Image size 2352x1568. Fundus photo. 45-degree field of view — 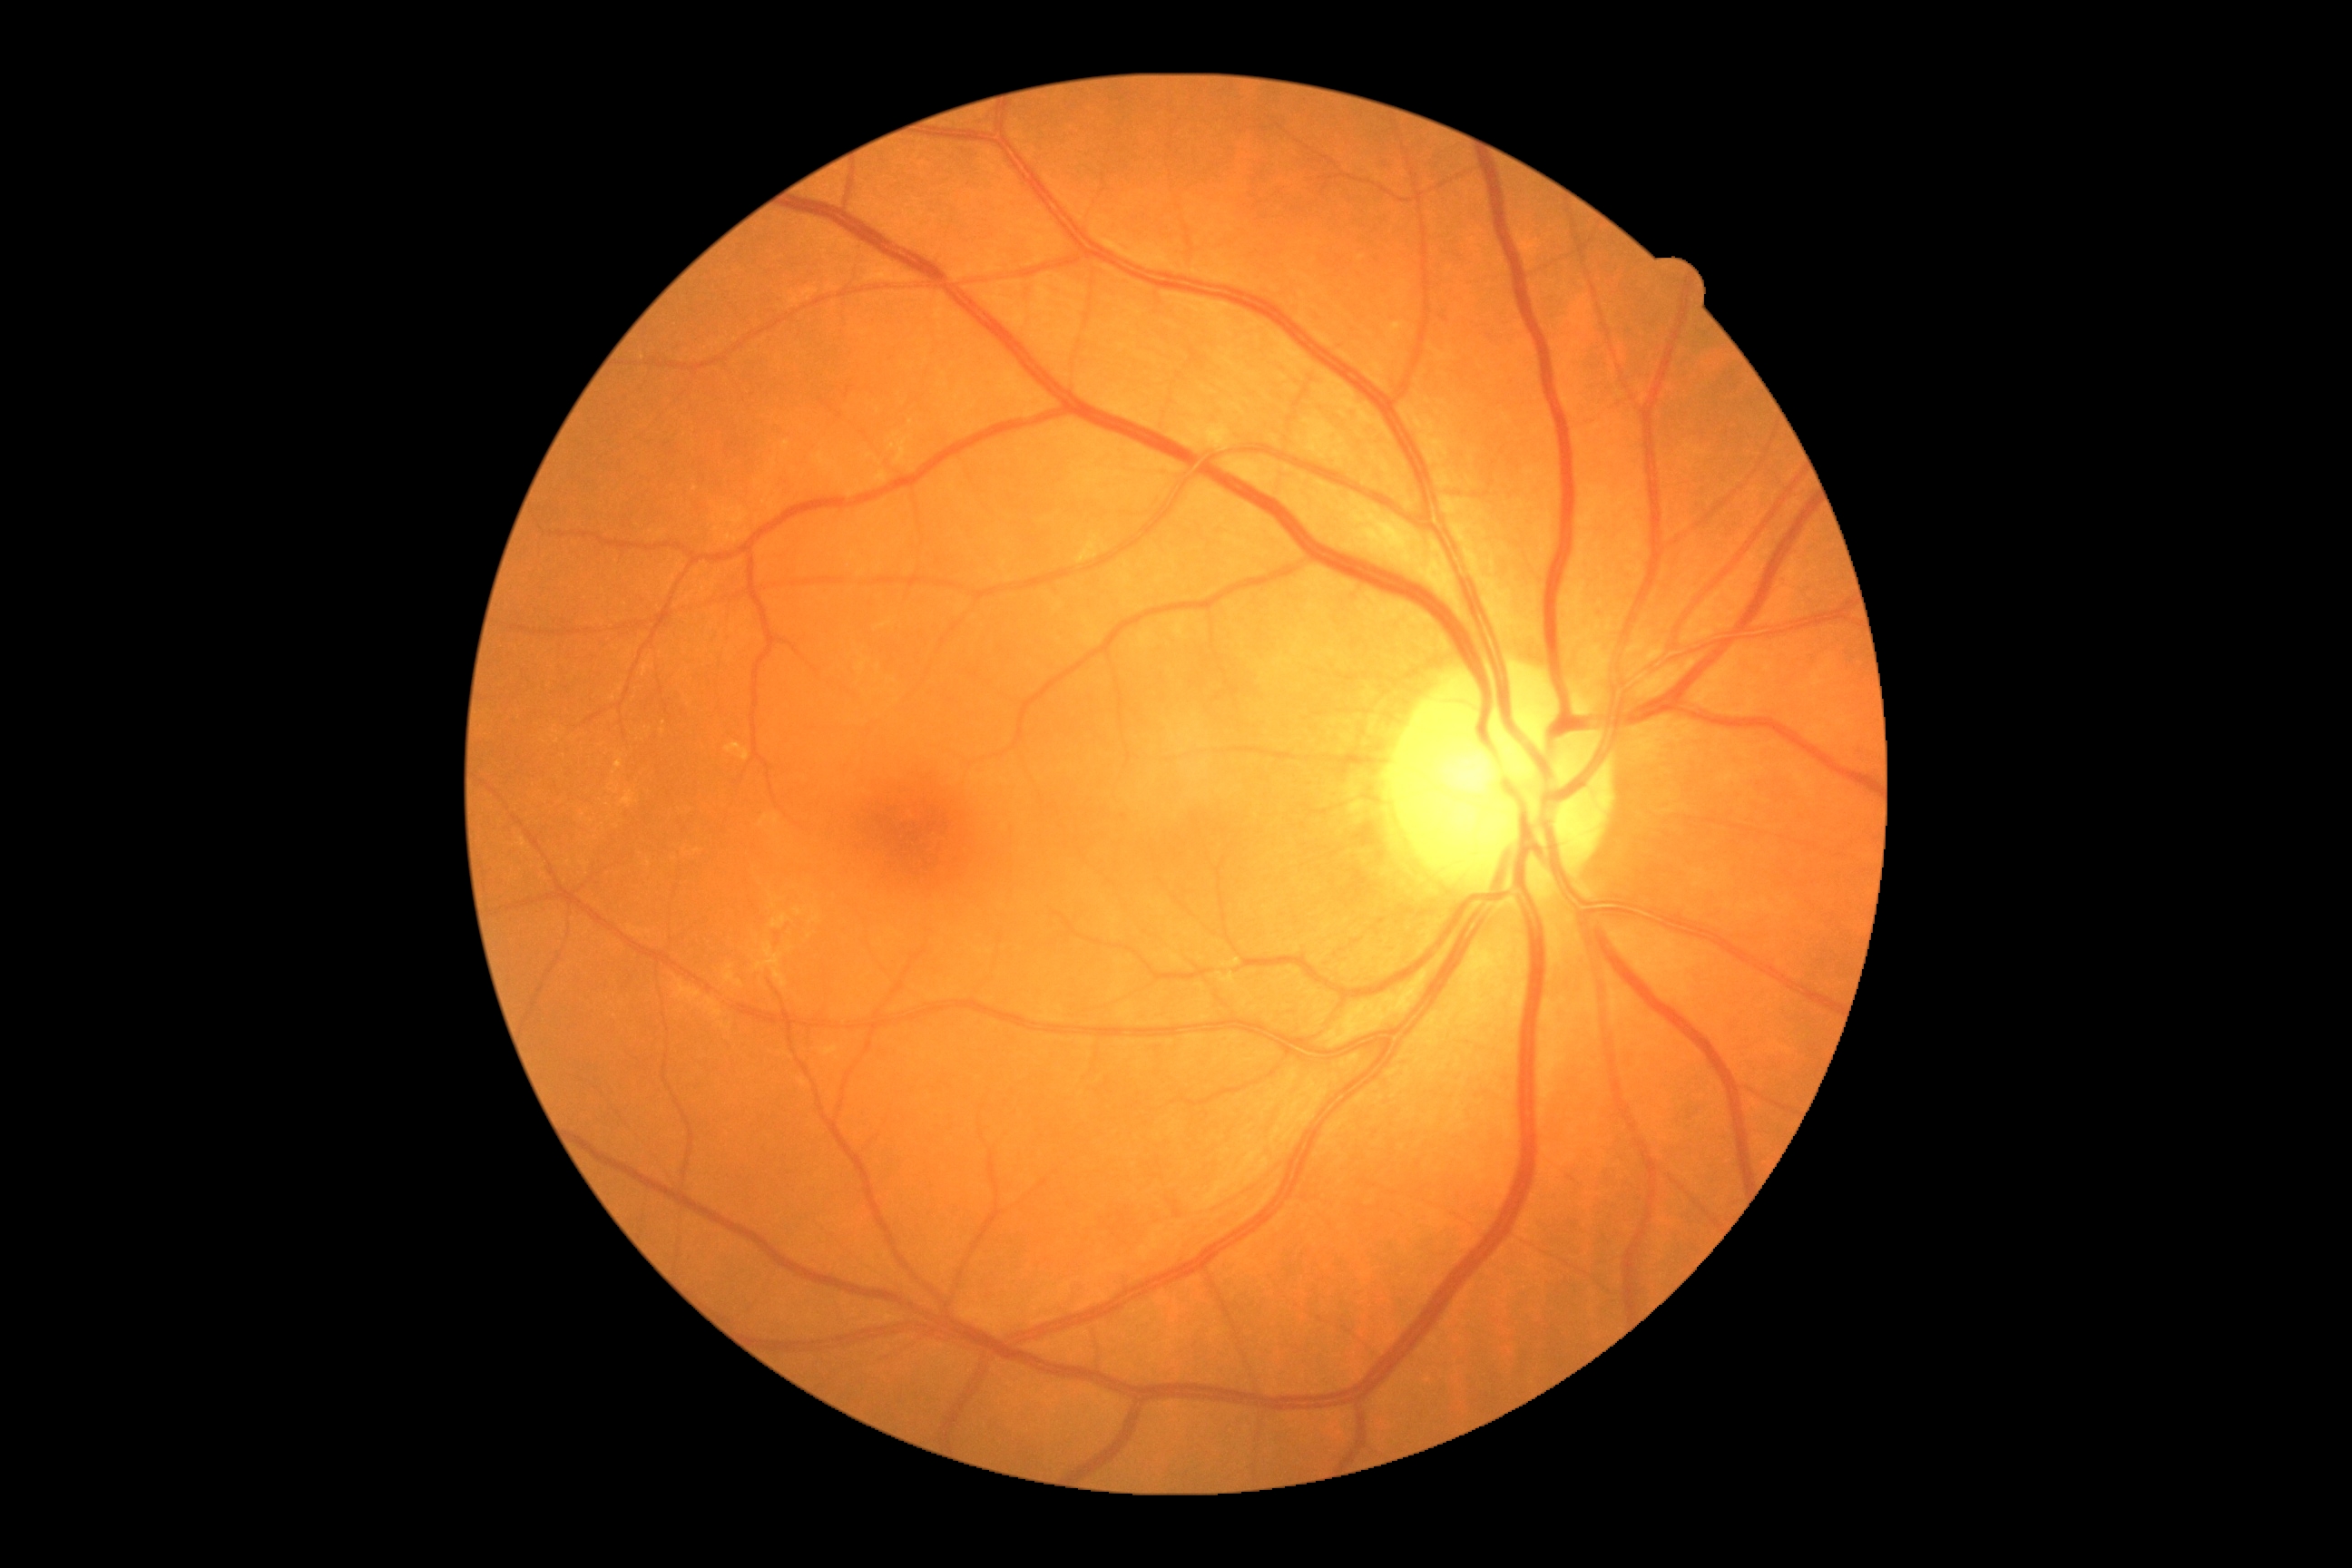   dr_grade: 0/4